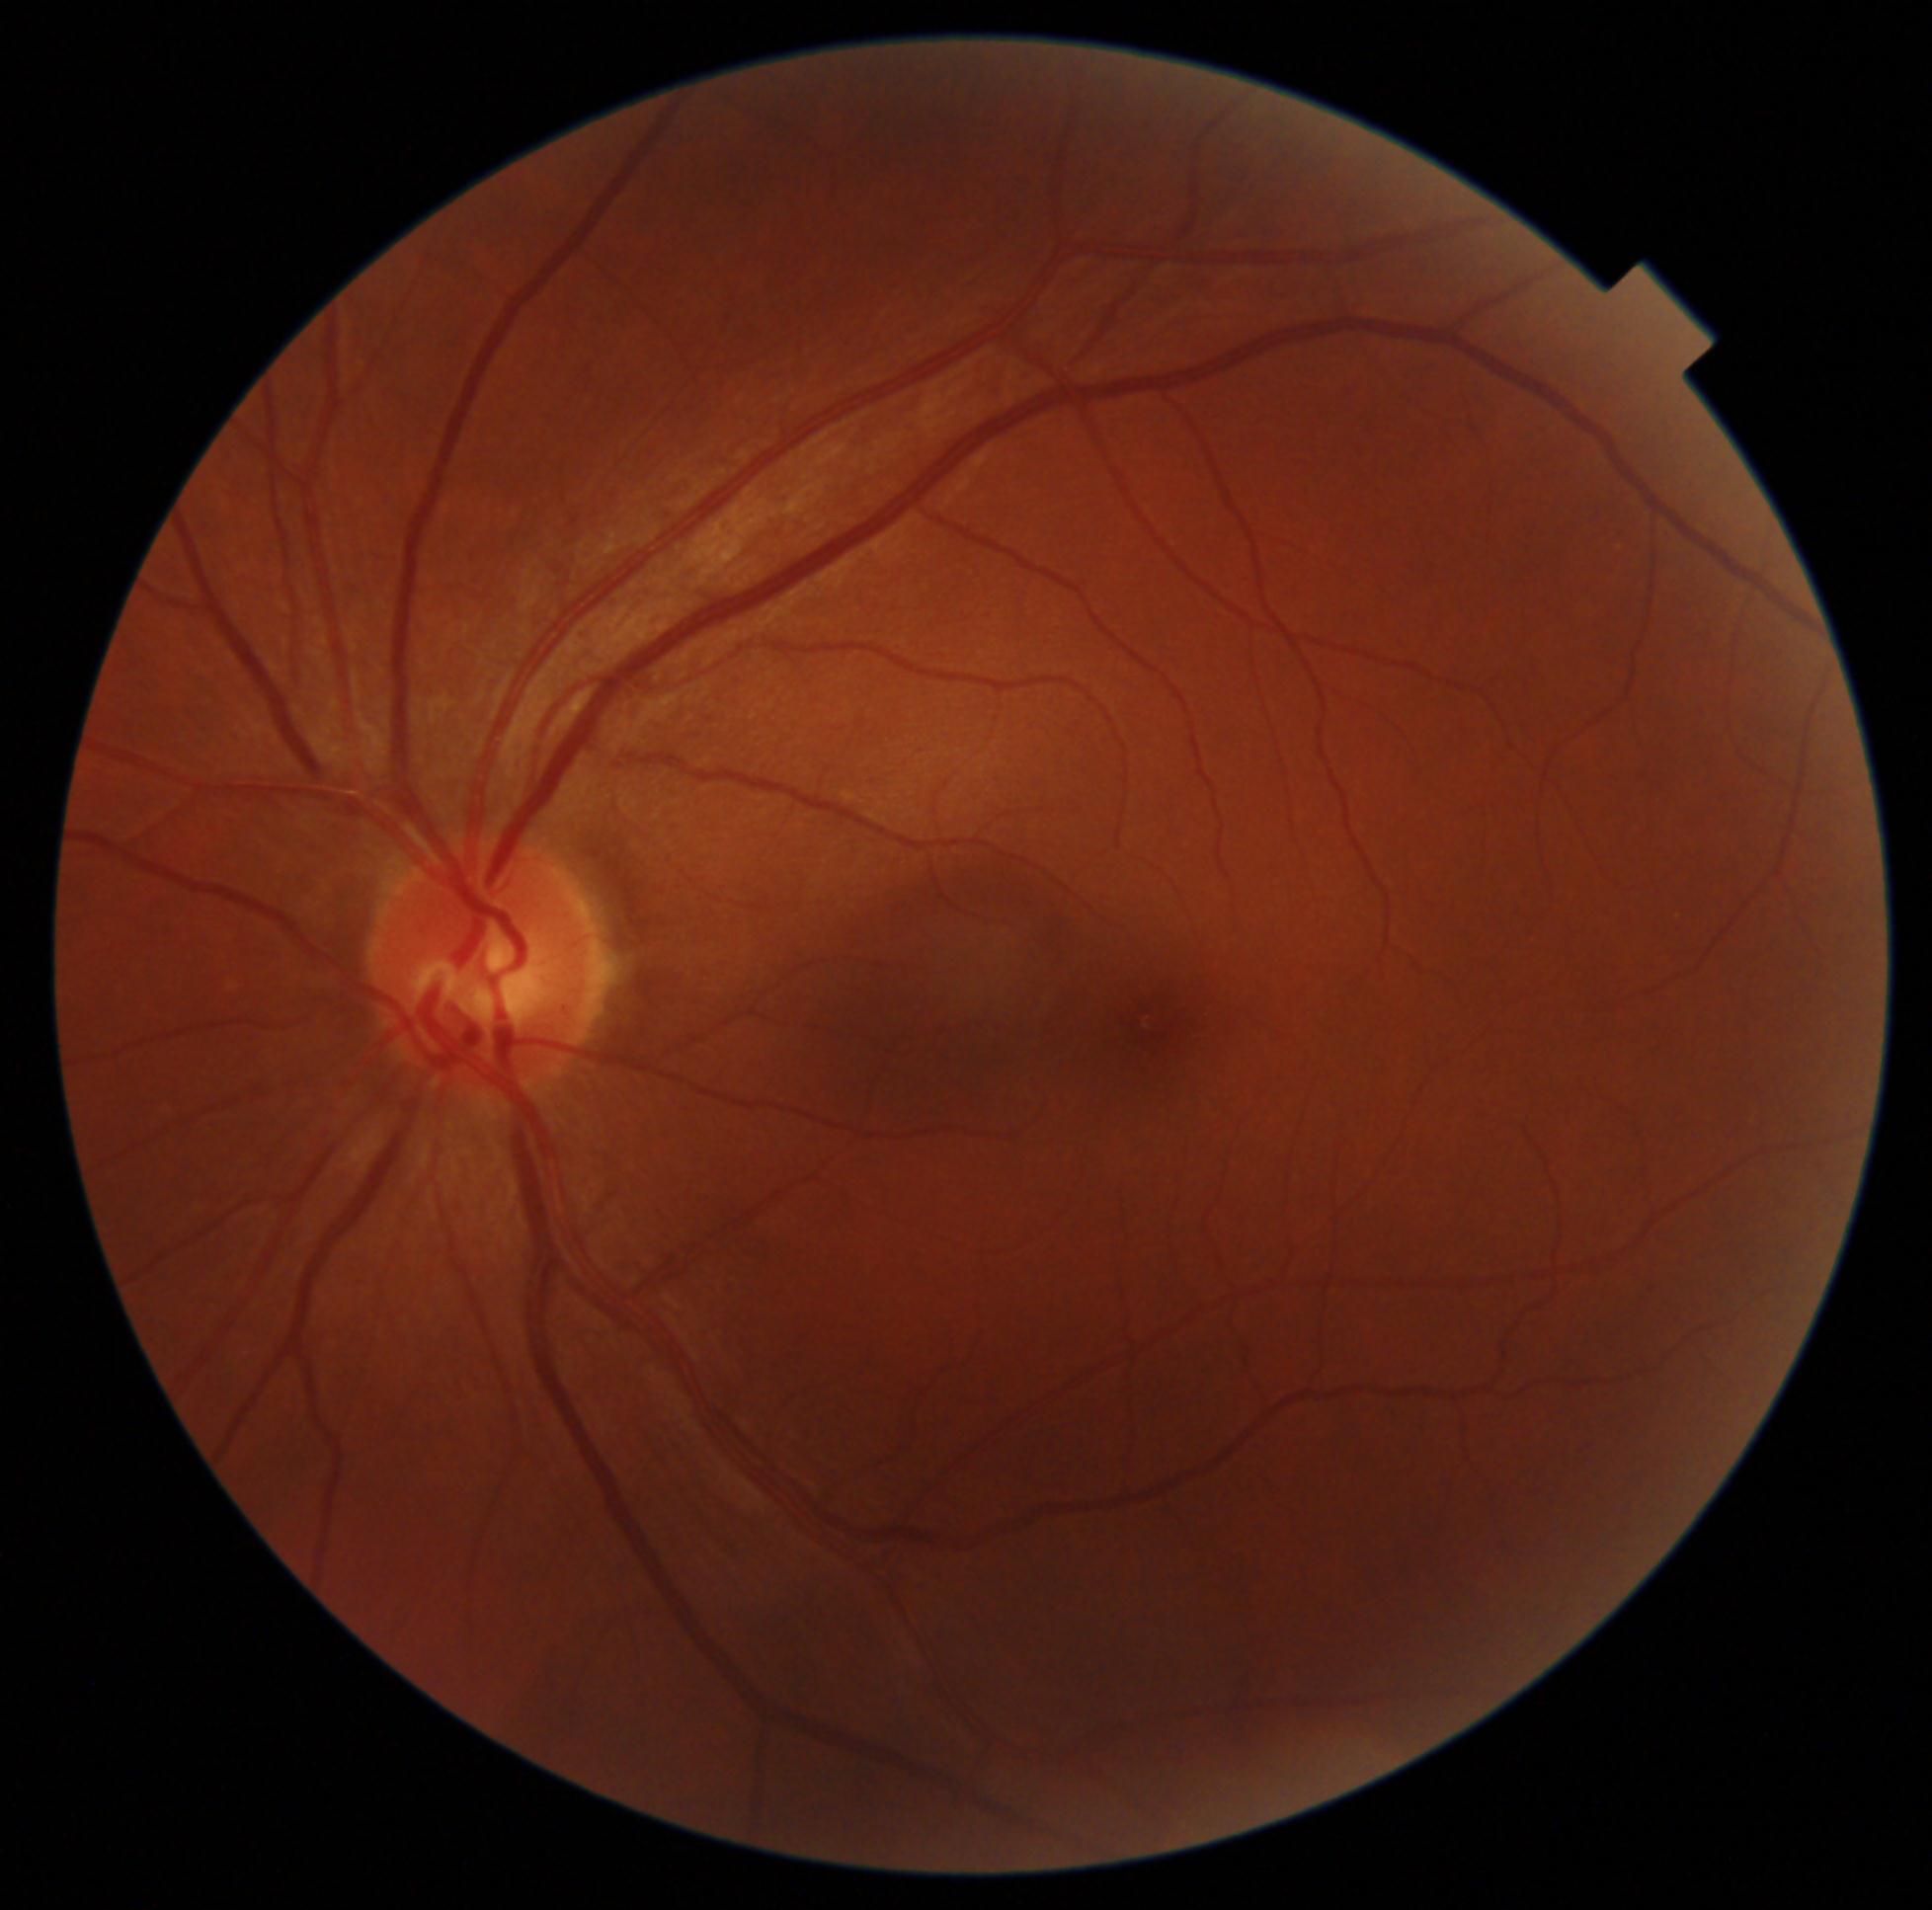

Diabetic retinopathy is grade 0 (no apparent retinopathy).